Color fundus image.
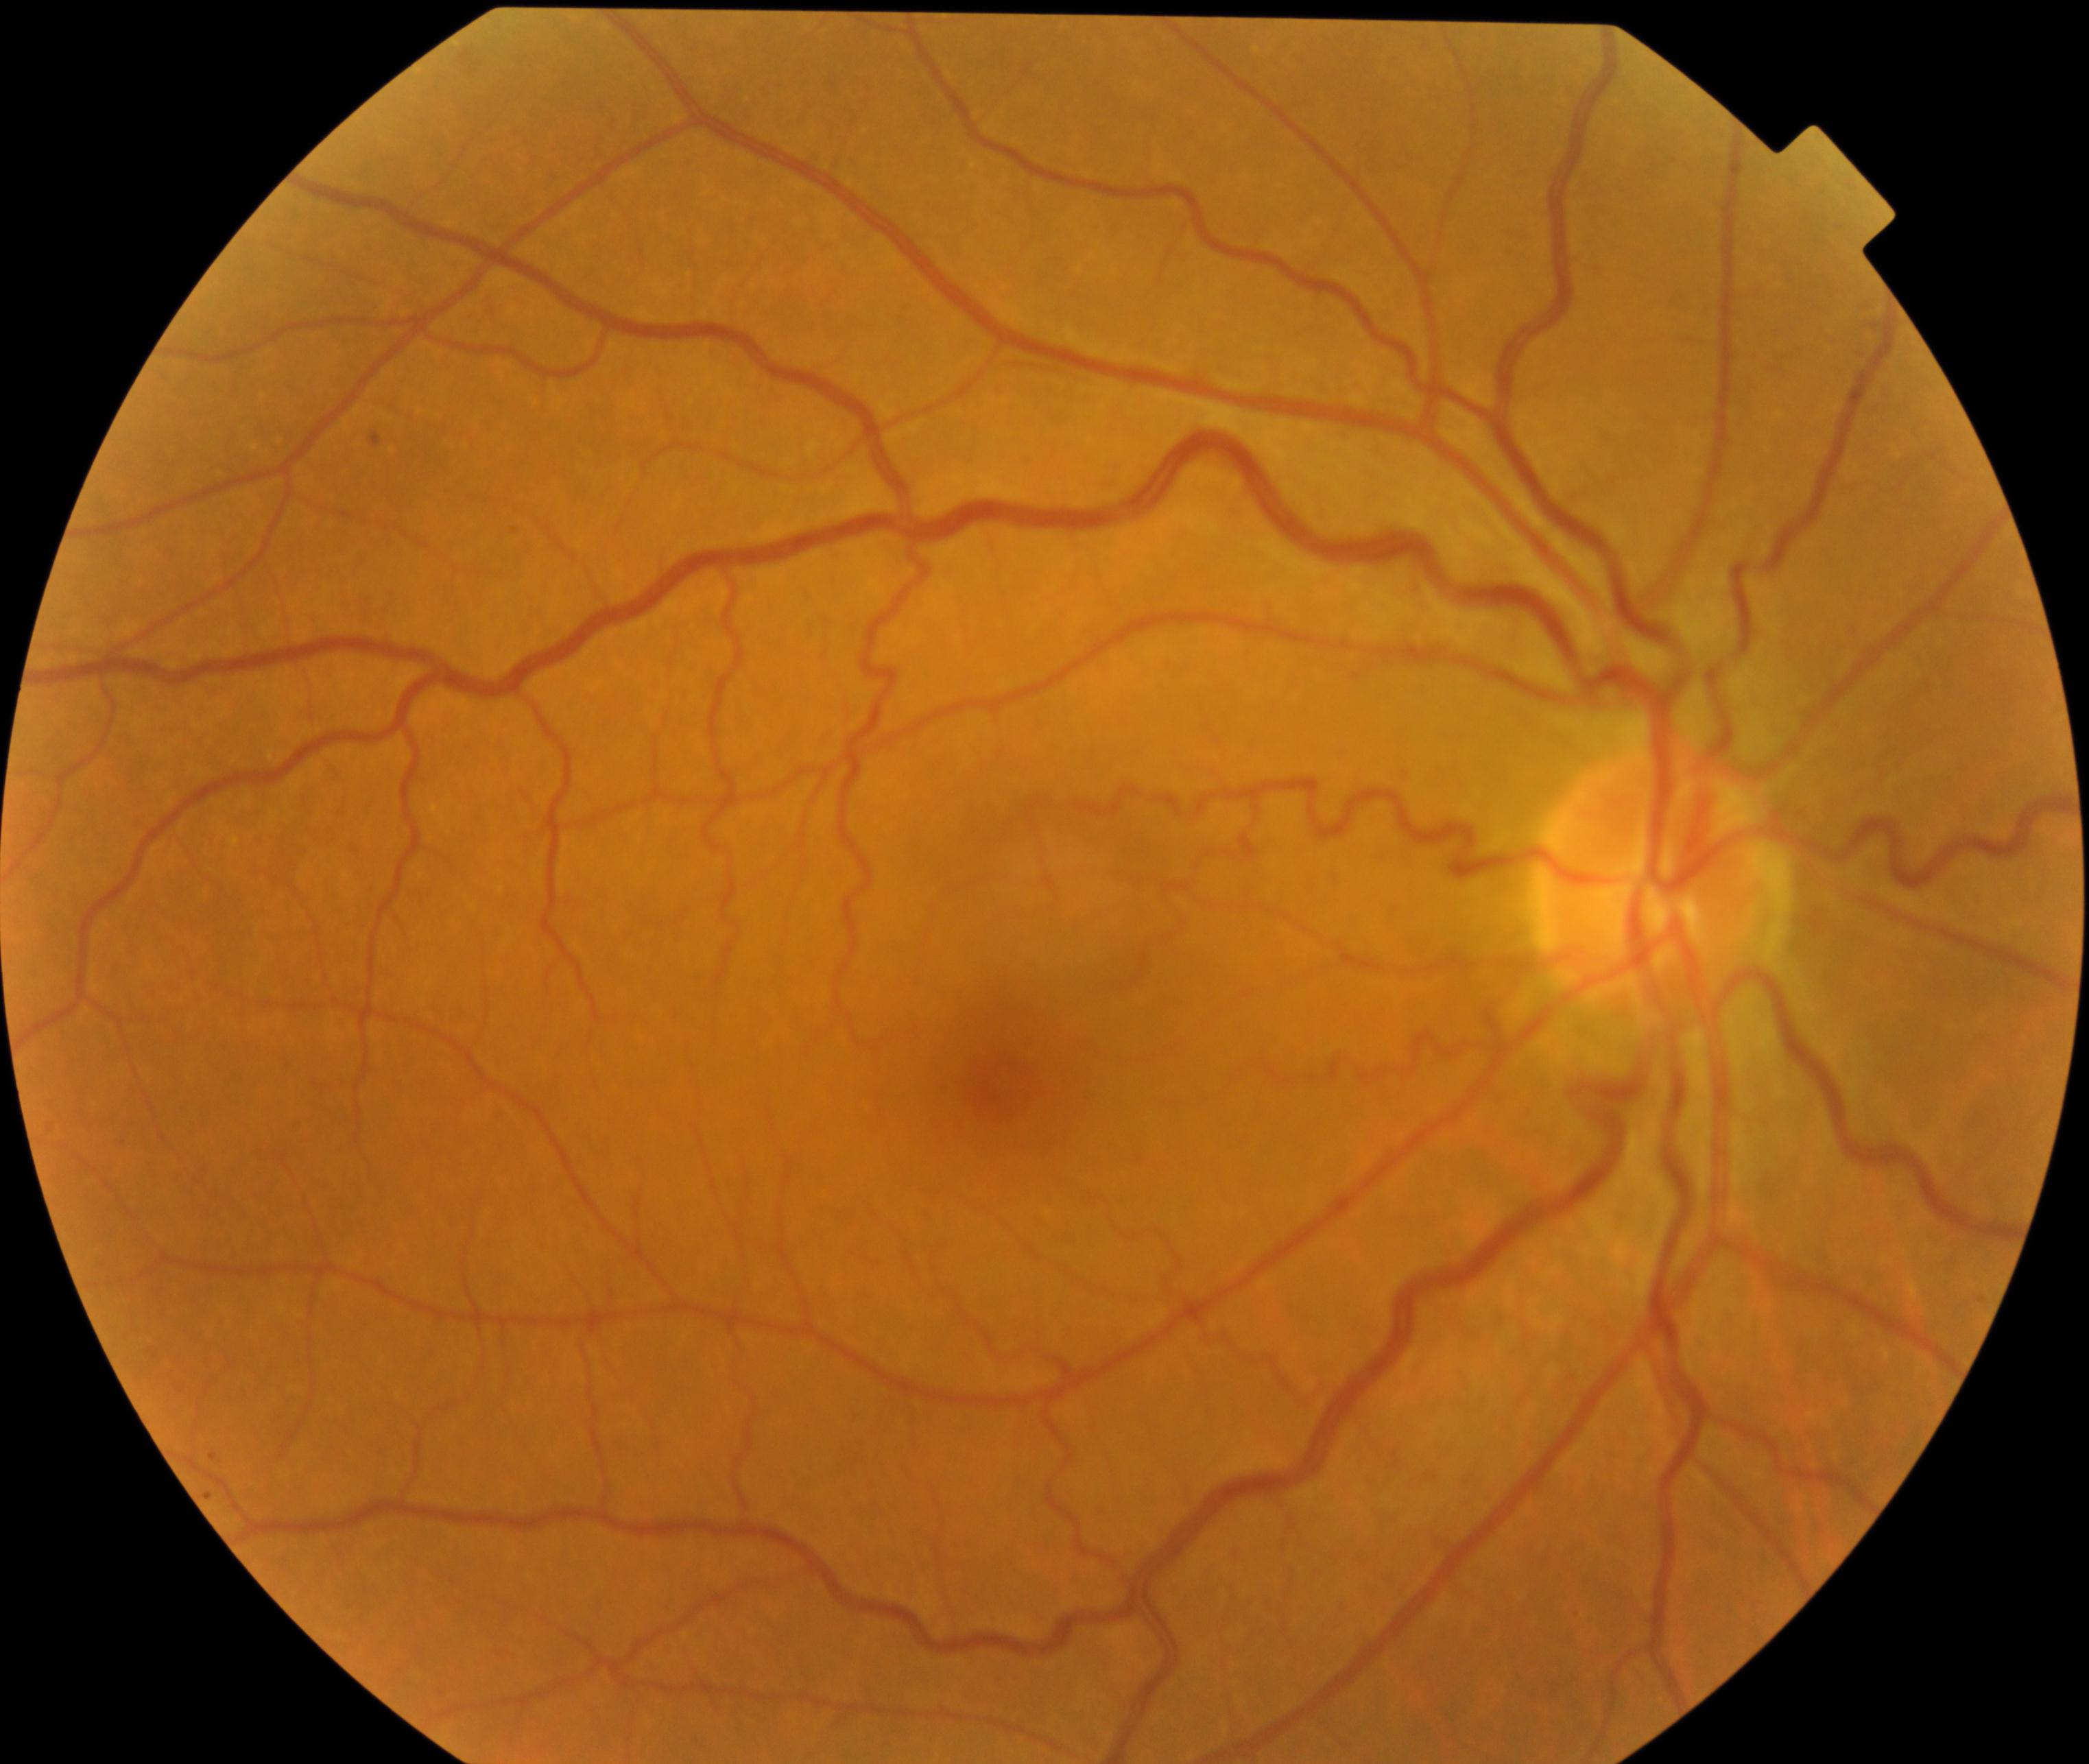 Impression: vessel tortuosity.